Modified Davis grading.
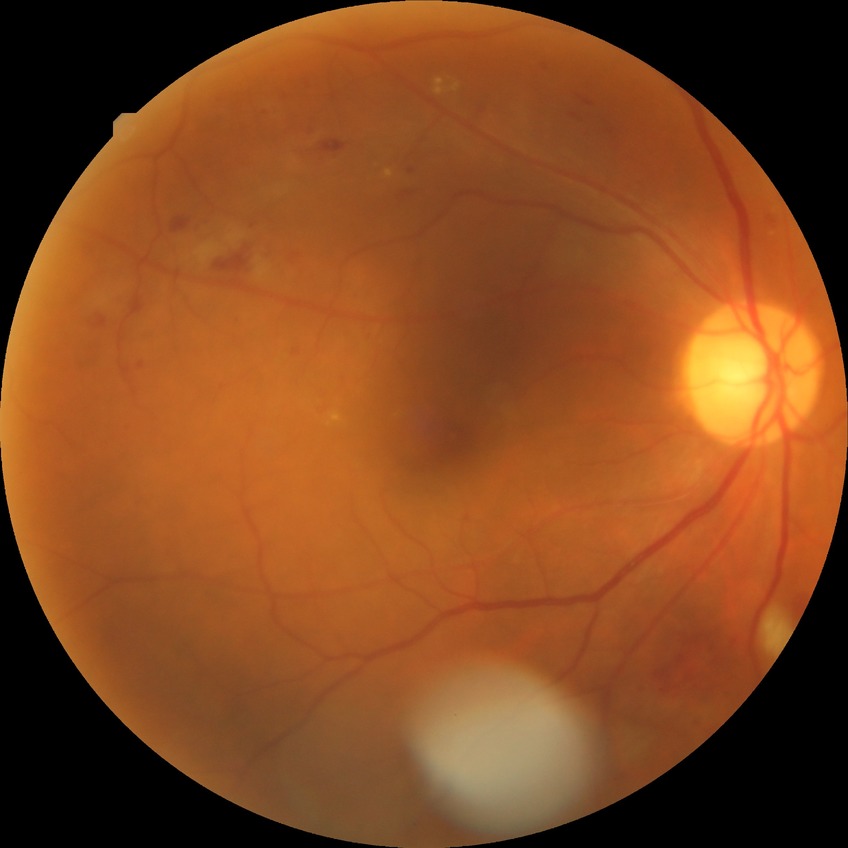
Davis grade is PPDR.